640x480; infant wide-field retinal image; 130° field of view (Clarity RetCam 3) — 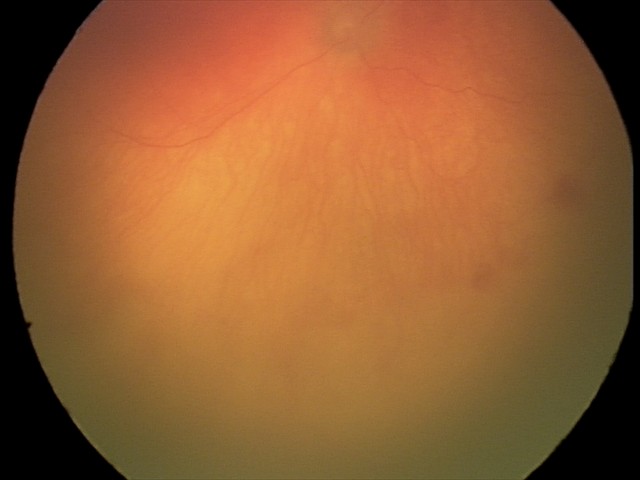 Examination diagnosed as aggressive retinopathy of prematurity (A-ROP) — rapidly progressive severe ROP with prominent plus disease, often without classic stage progression.
Plus disease present.